Color fundus photograph — 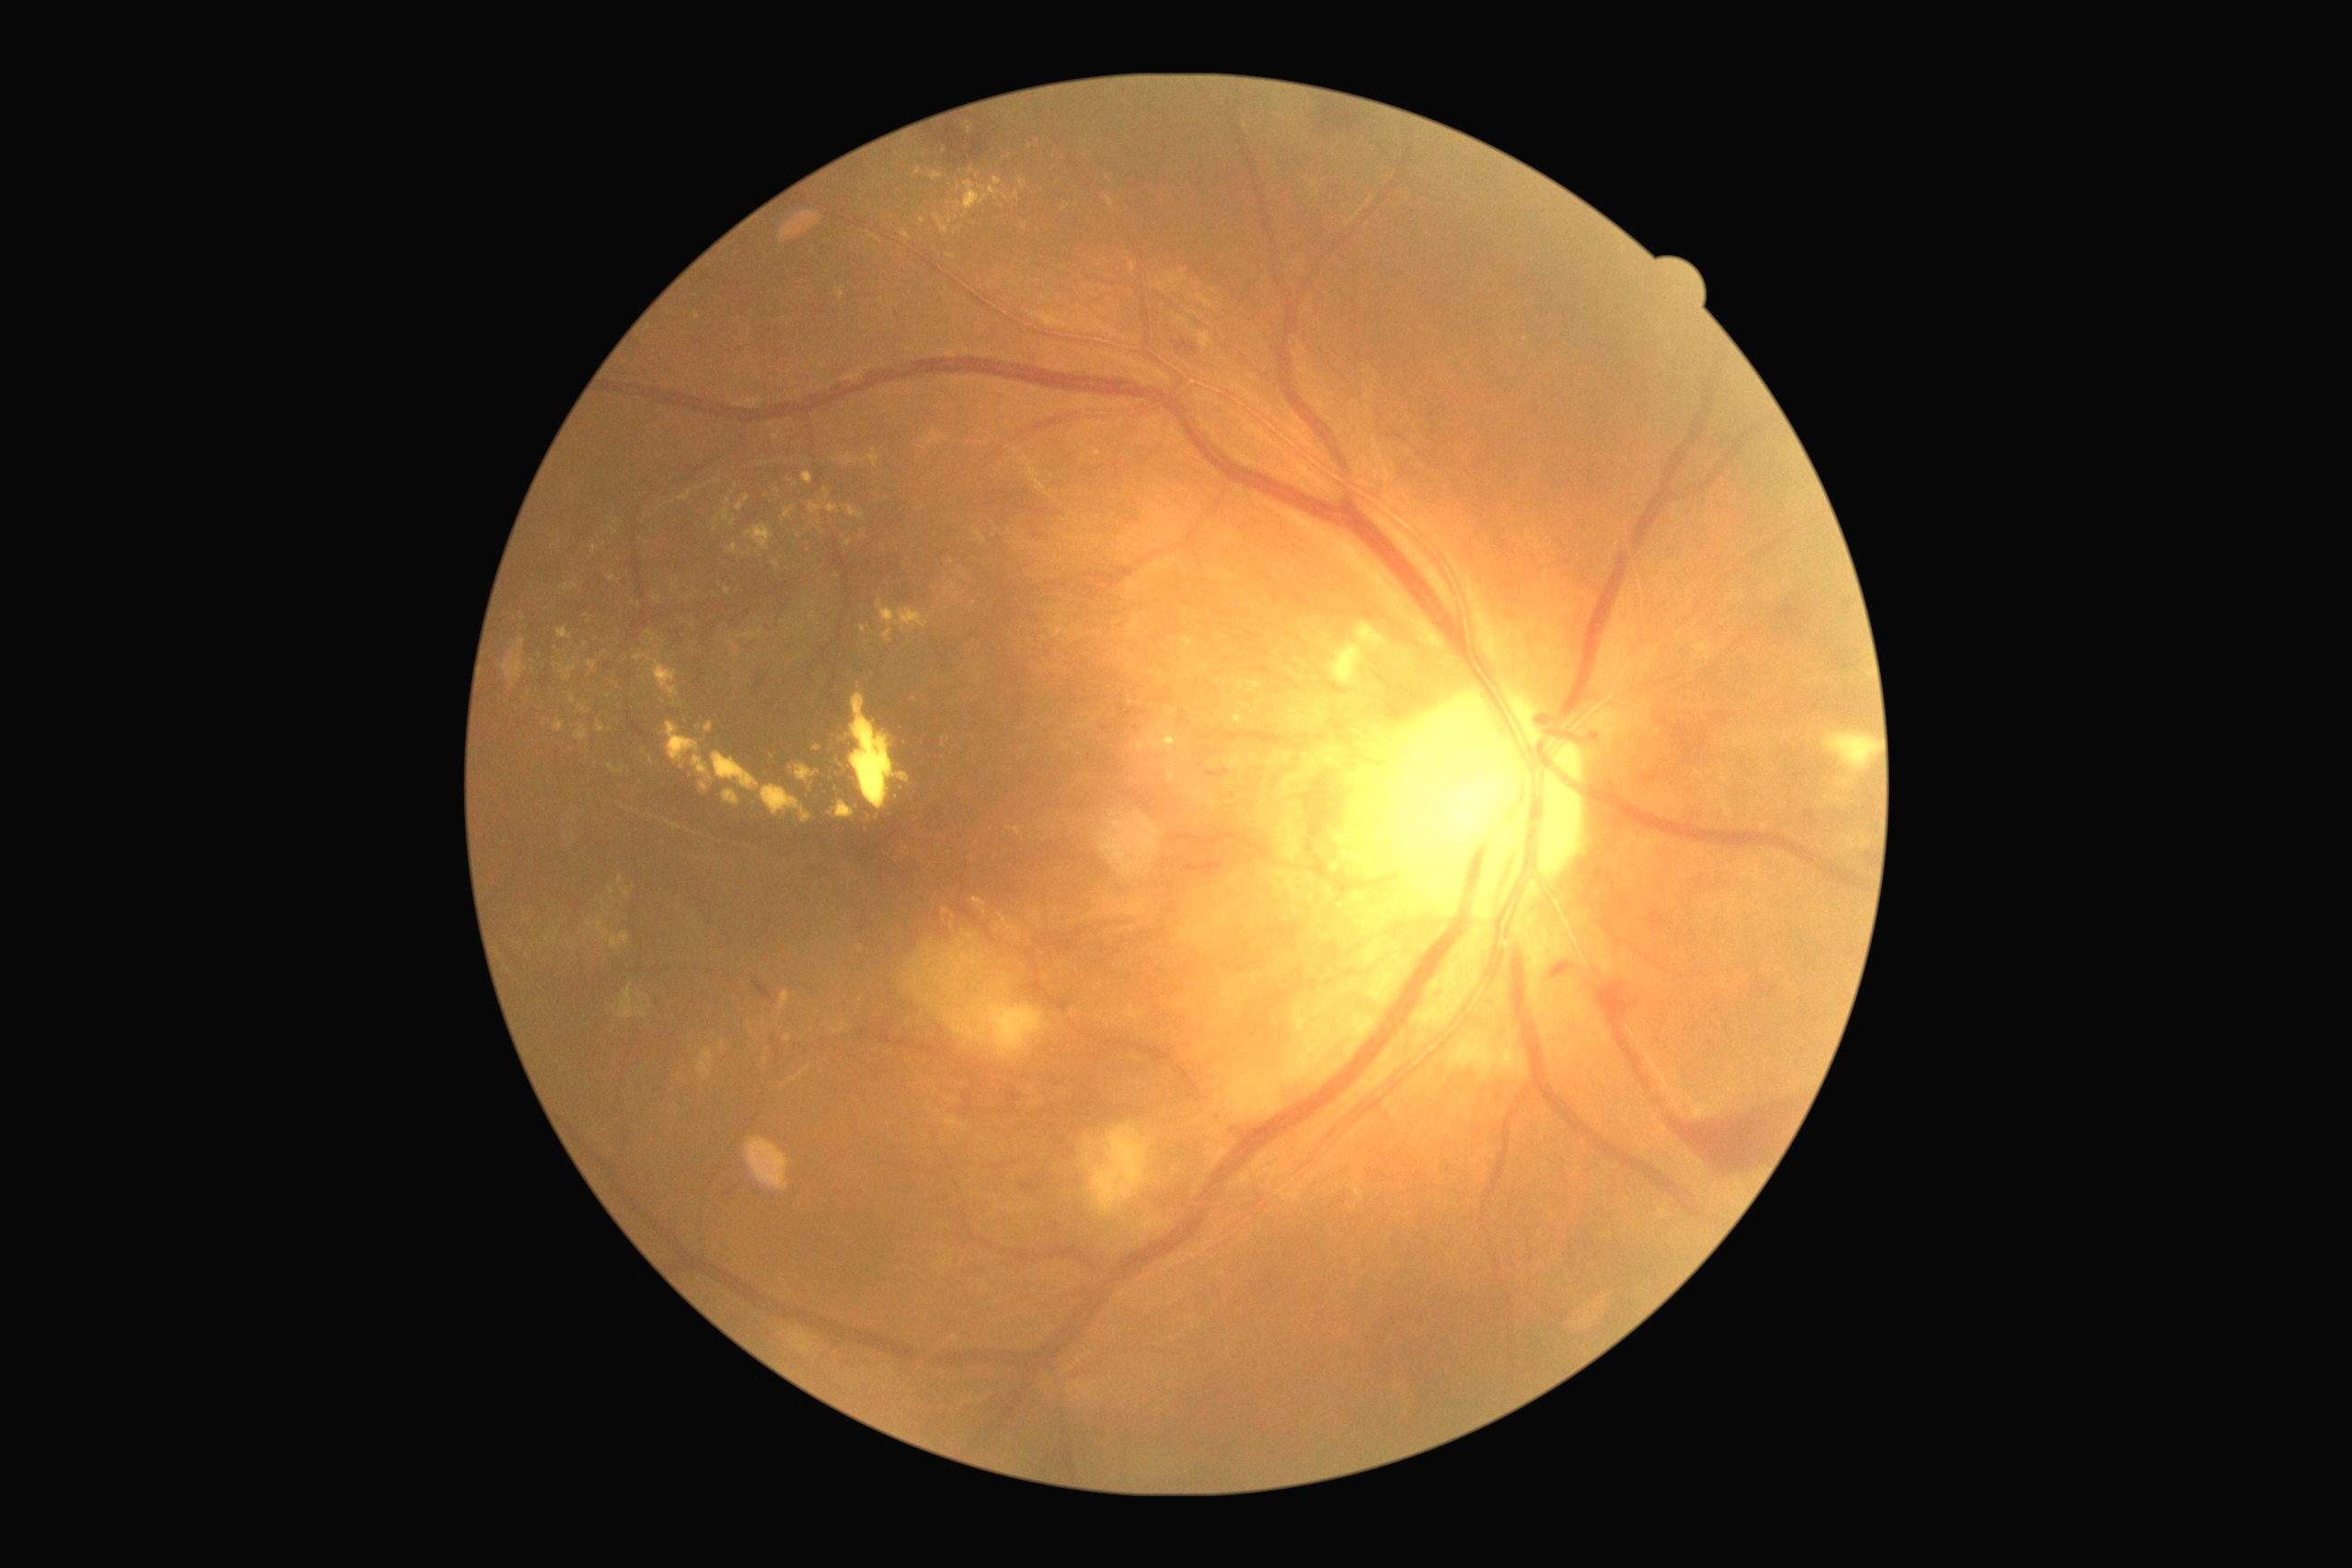
DR stage is PDR (grade 4)
Representative lesions:
EXs (partial): {"x1": 945, "y1": 1117, "x2": 968, "y2": 1133}, {"x1": 1128, "y1": 260, "x2": 1137, "y2": 273}, {"x1": 1696, "y1": 643, "x2": 1712, "y2": 660}, {"x1": 1028, "y1": 311, "x2": 1068, "y2": 328}, {"x1": 838, "y1": 289, "x2": 845, "y2": 300}, {"x1": 930, "y1": 172, "x2": 943, "y2": 182}, {"x1": 830, "y1": 1024, "x2": 847, "y2": 1035}, {"x1": 547, "y1": 937, "x2": 551, "y2": 945}, {"x1": 1003, "y1": 191, "x2": 1021, "y2": 202}, {"x1": 652, "y1": 596, "x2": 662, "y2": 603}, {"x1": 1106, "y1": 197, "x2": 1115, "y2": 208}, {"x1": 876, "y1": 602, "x2": 930, "y2": 643}, {"x1": 785, "y1": 1035, "x2": 792, "y2": 1043}
Small EXs approximately at x=952 y=926, x=915 y=699, x=945 y=911, x=817 y=749, x=1109 y=179, x=627 y=768